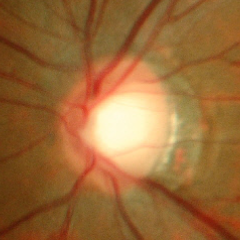
Early glaucomatous optic neuropathy.